DR severity per modified Davis staging
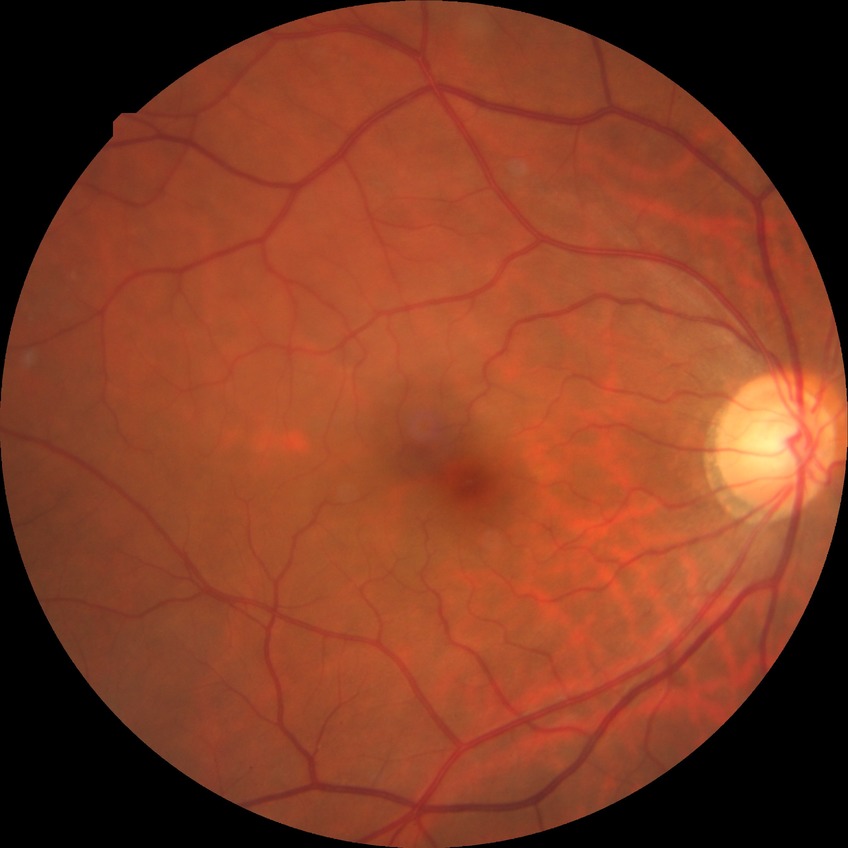
Assessment:
• retinopathy stage — no diabetic retinopathy